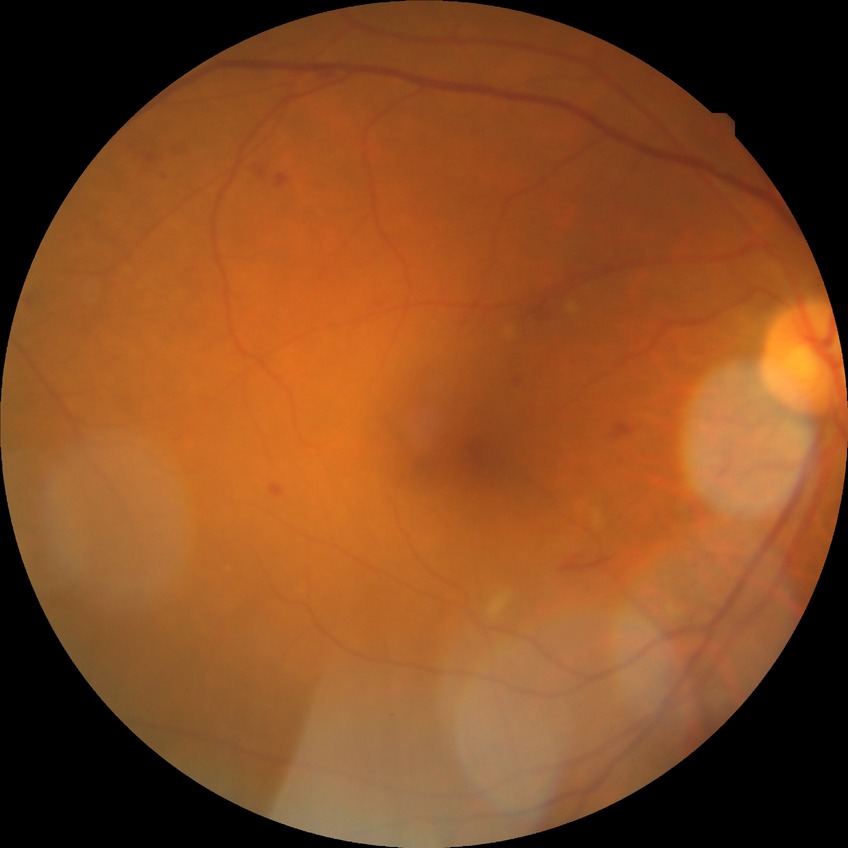 Diabetic retinopathy (DR) is simple diabetic retinopathy (SDR).